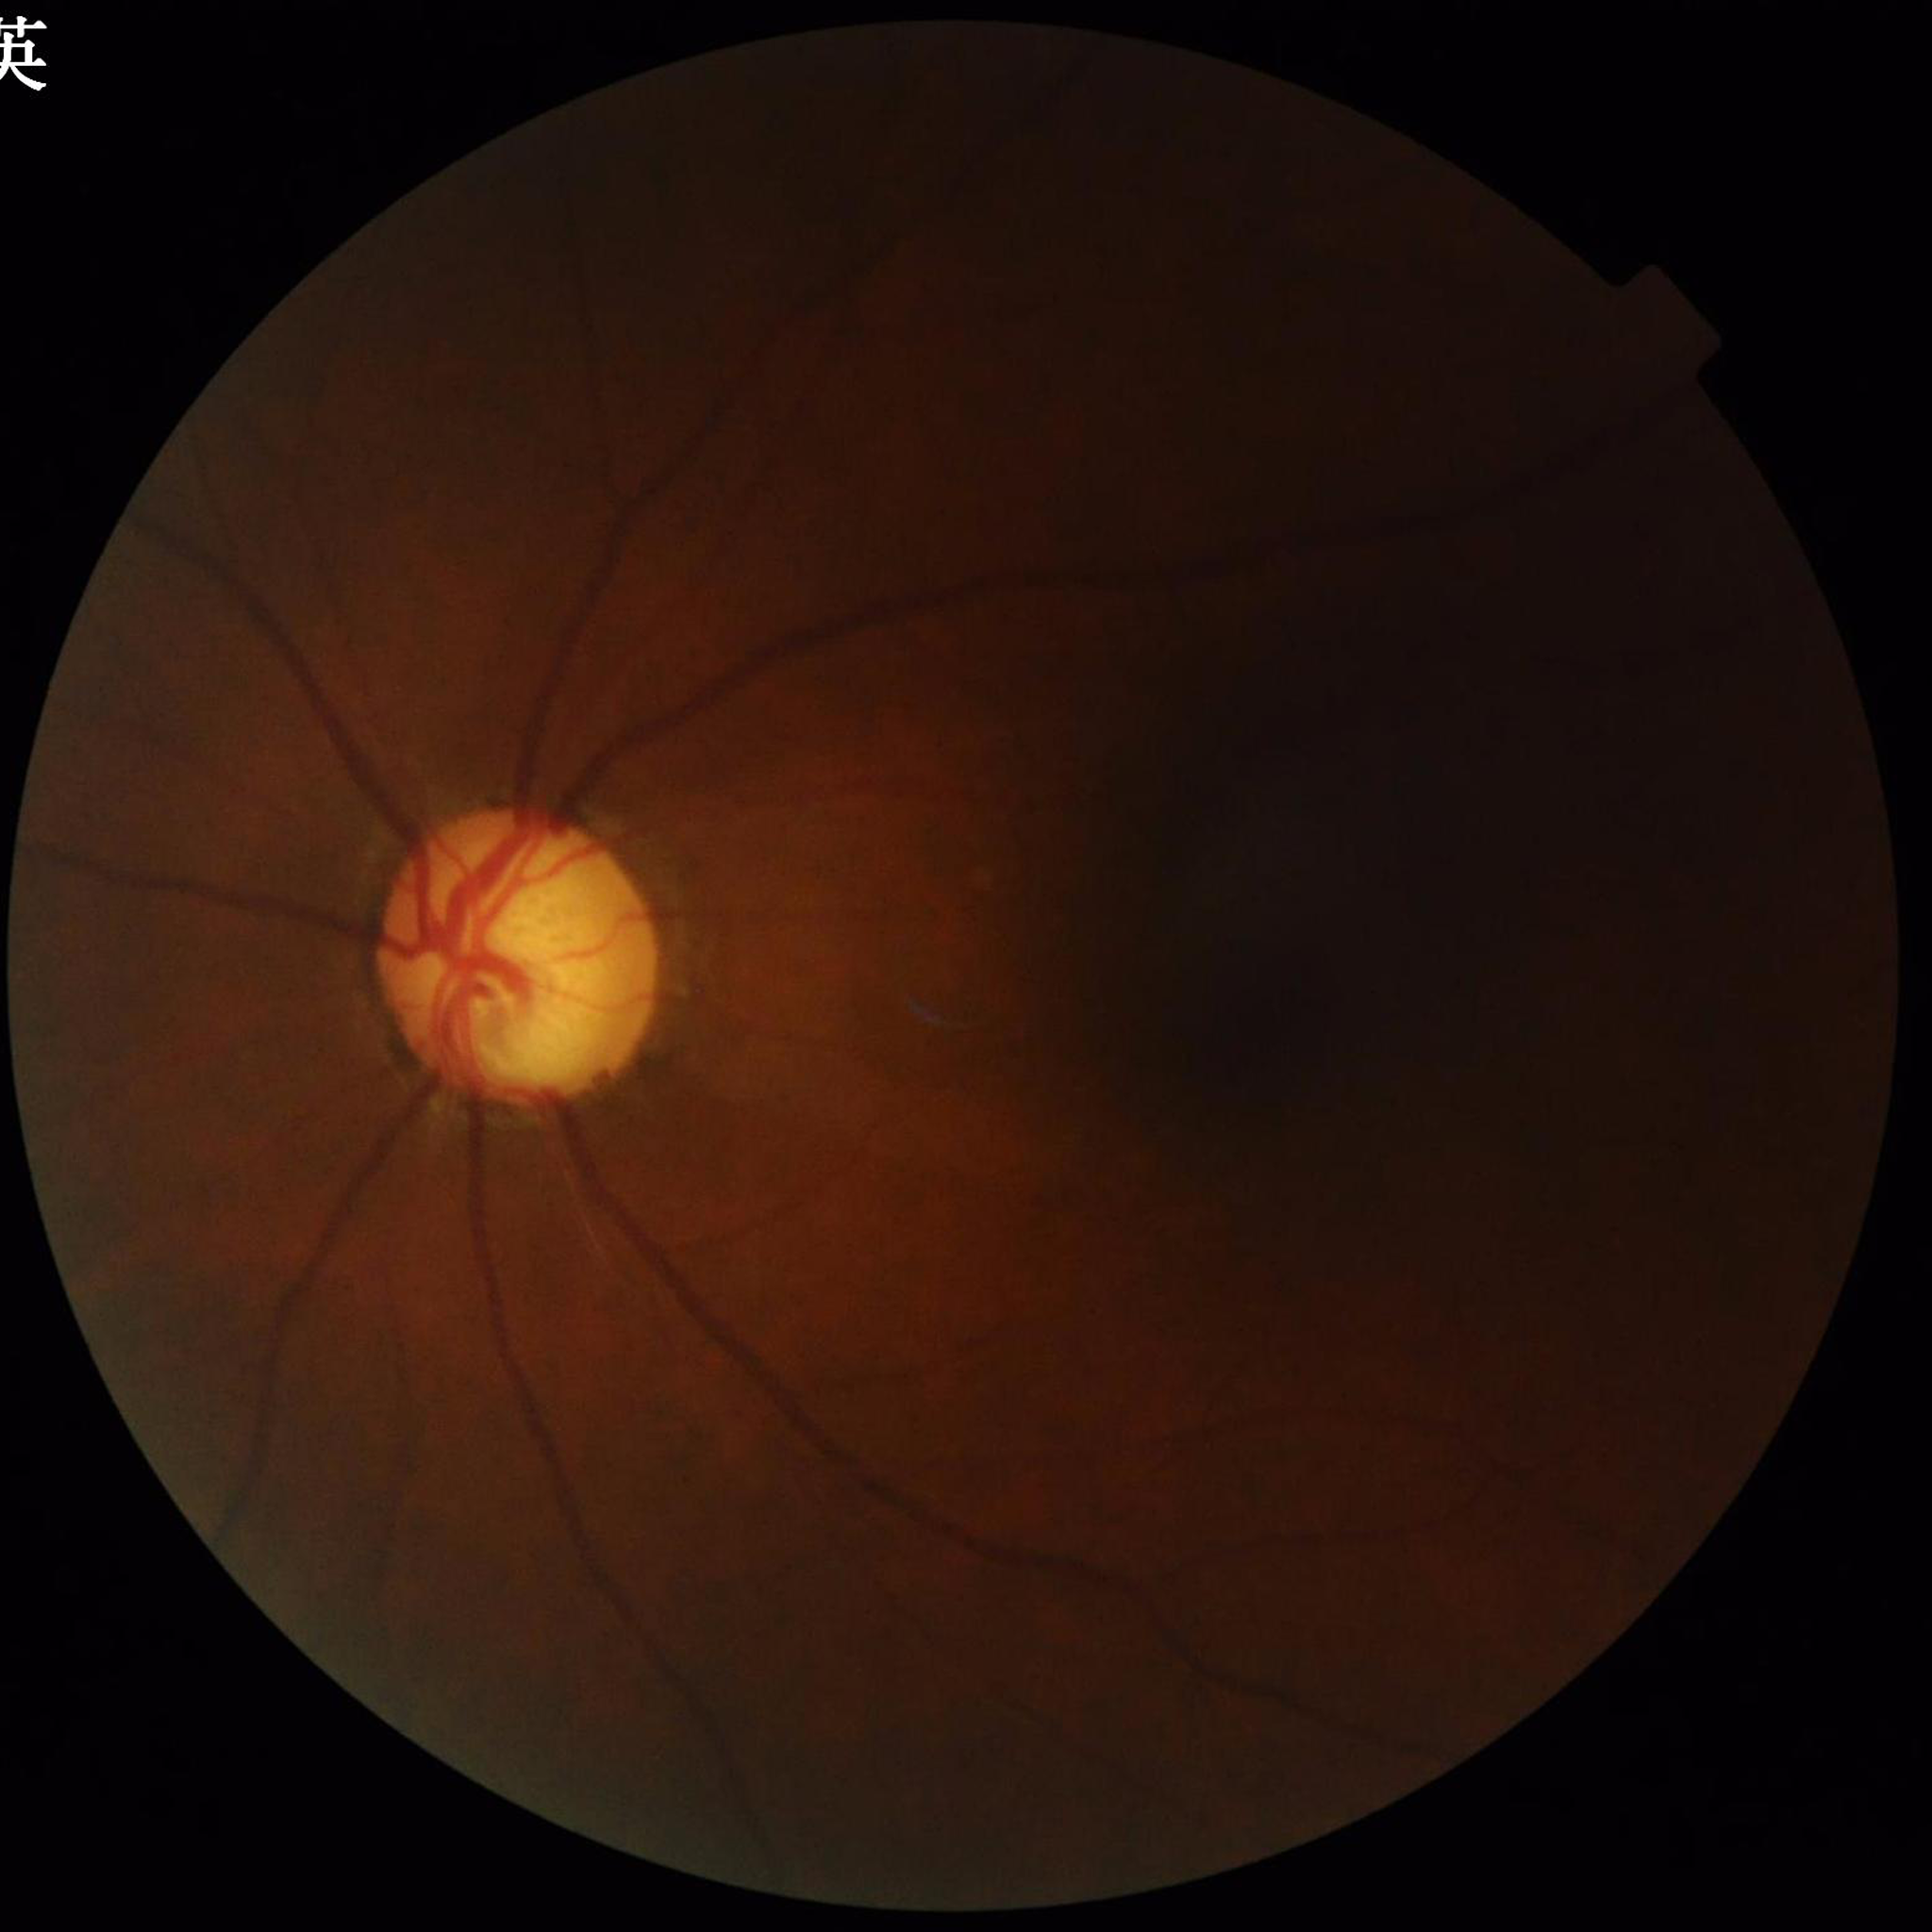
diagnosis: glaucoma